45 degree fundus photograph; NIDEK AFC-230 fundus camera; diabetic retinopathy graded by the modified Davis classification; fundus photo
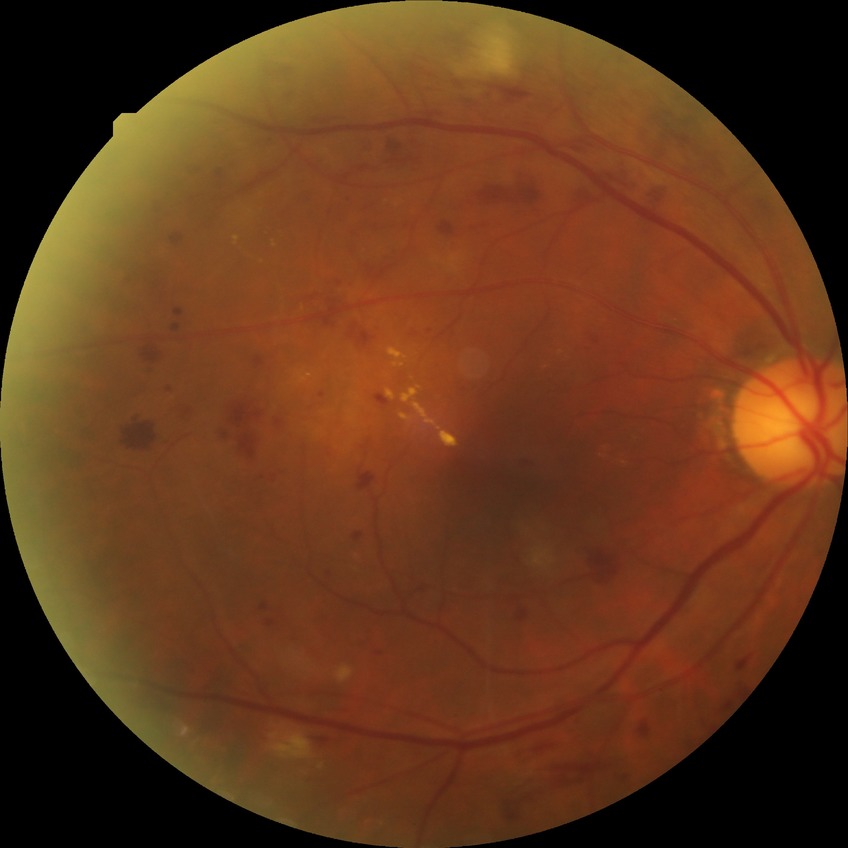
Davis grading: pre-proliferative diabetic retinopathy